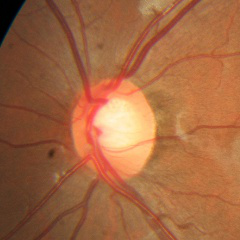

No glaucomatous optic neuropathy.